45° field of view · fundus photo · 2048x1536px — 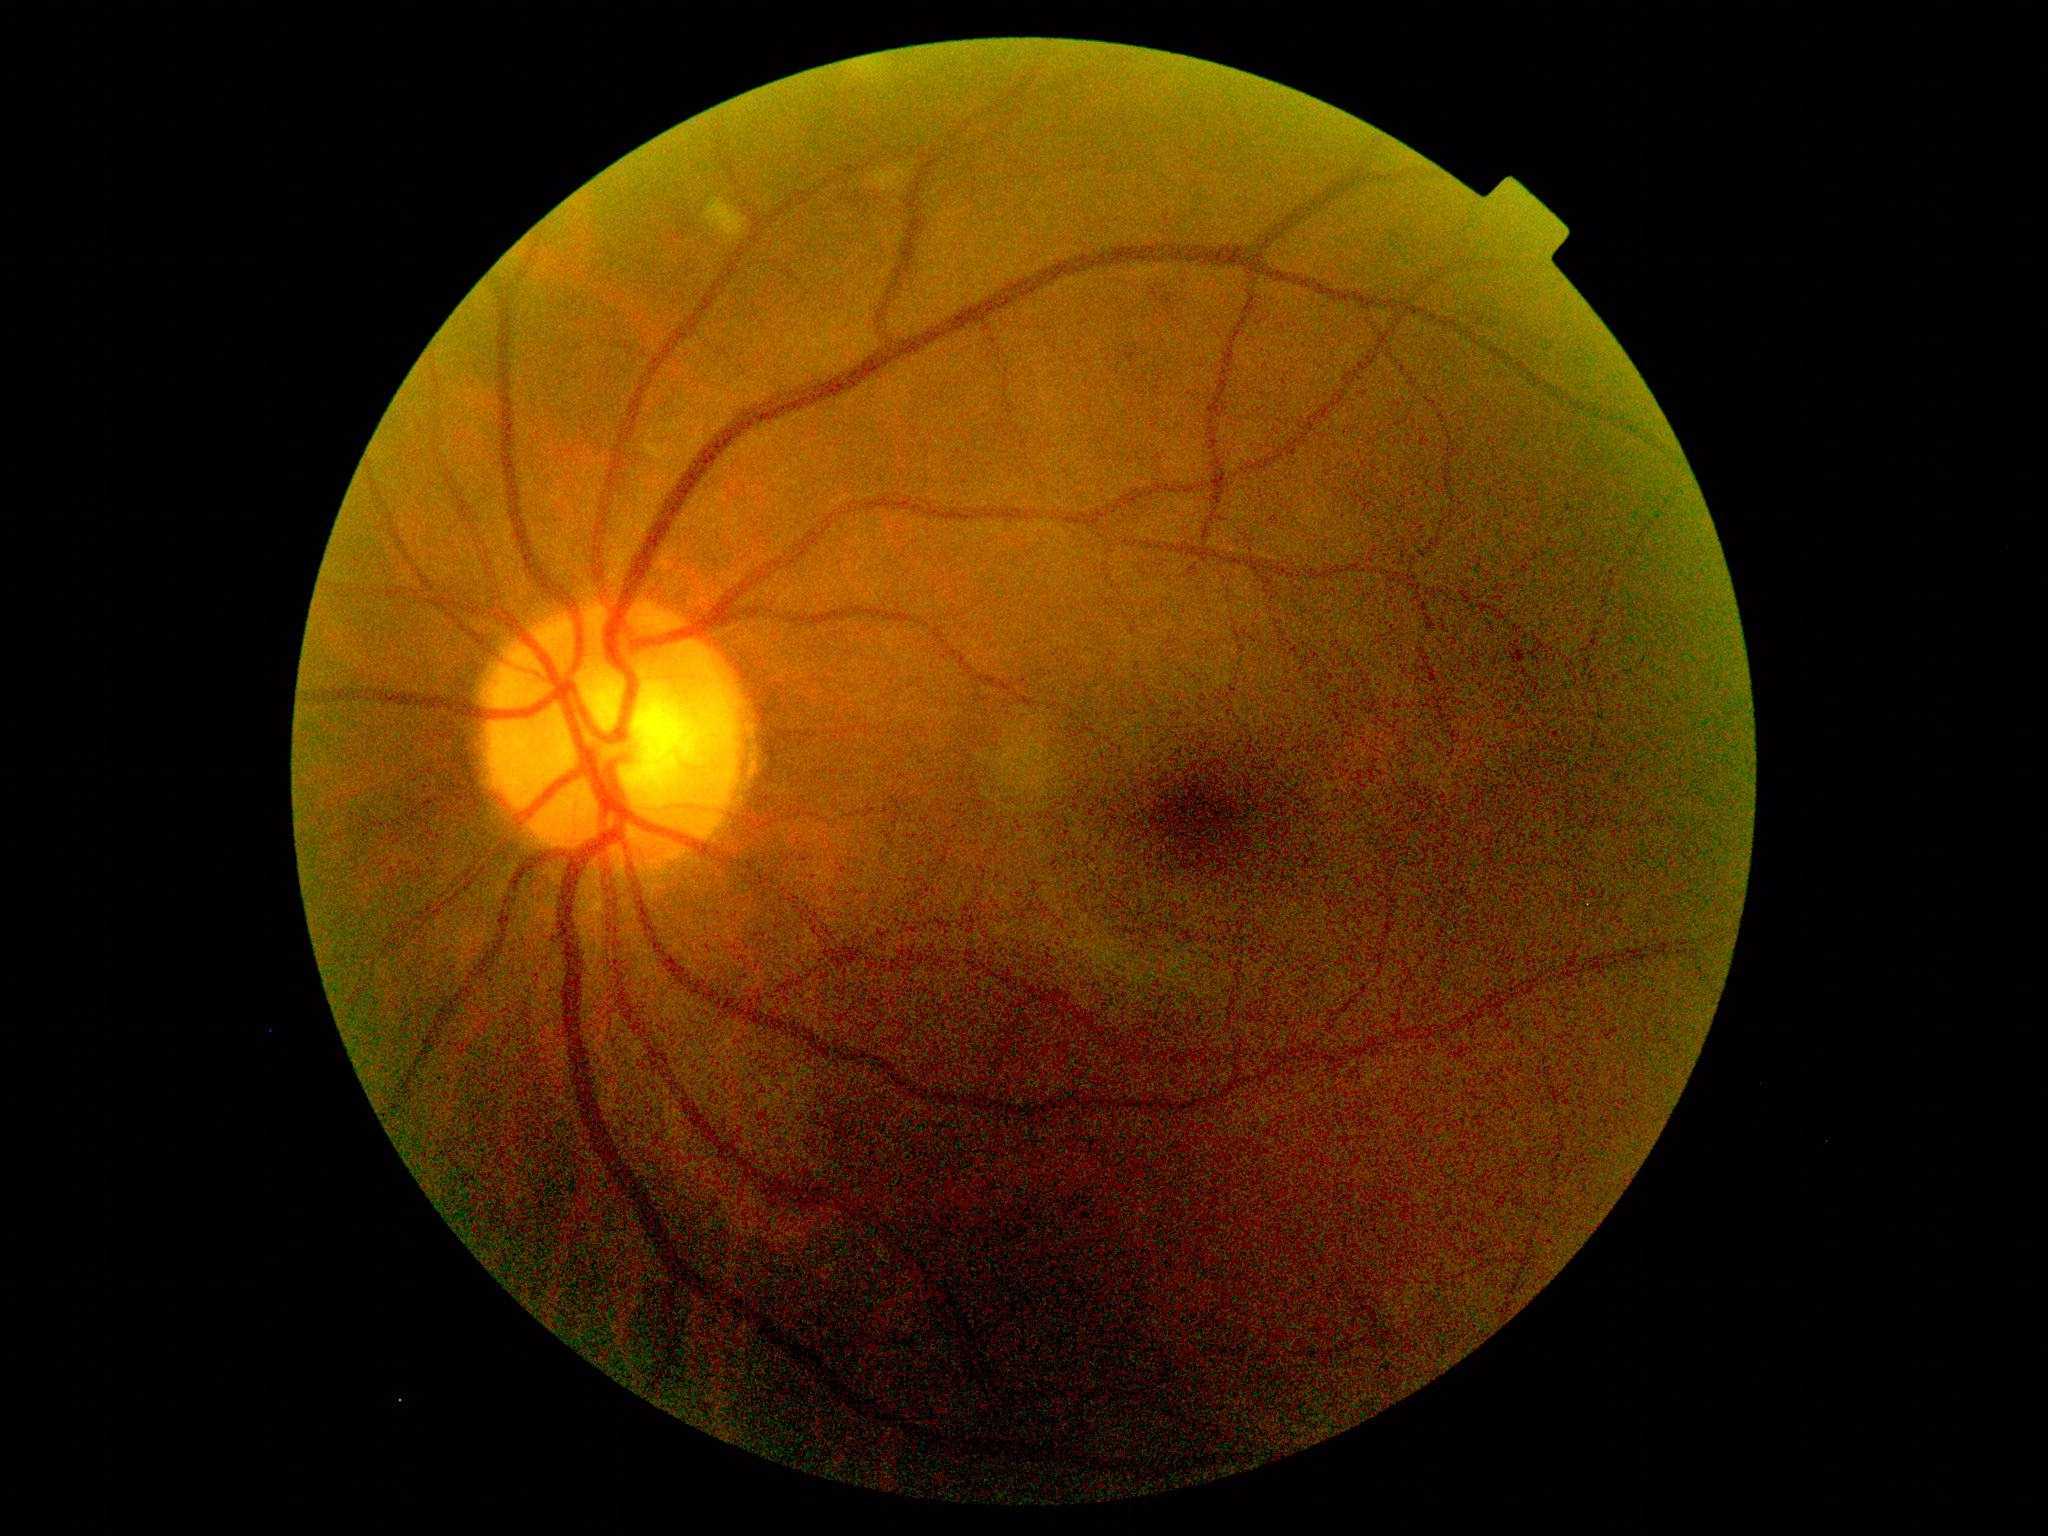 DR grade: 2.